512 by 512 pixels. Retinal fundus photograph: 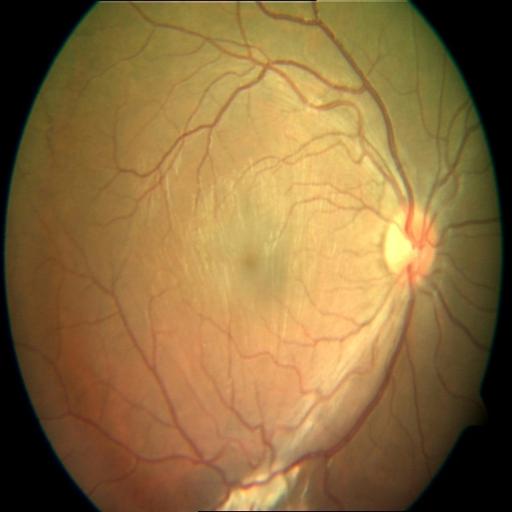 Impression: RT (retinal traction), MS (macular scar).